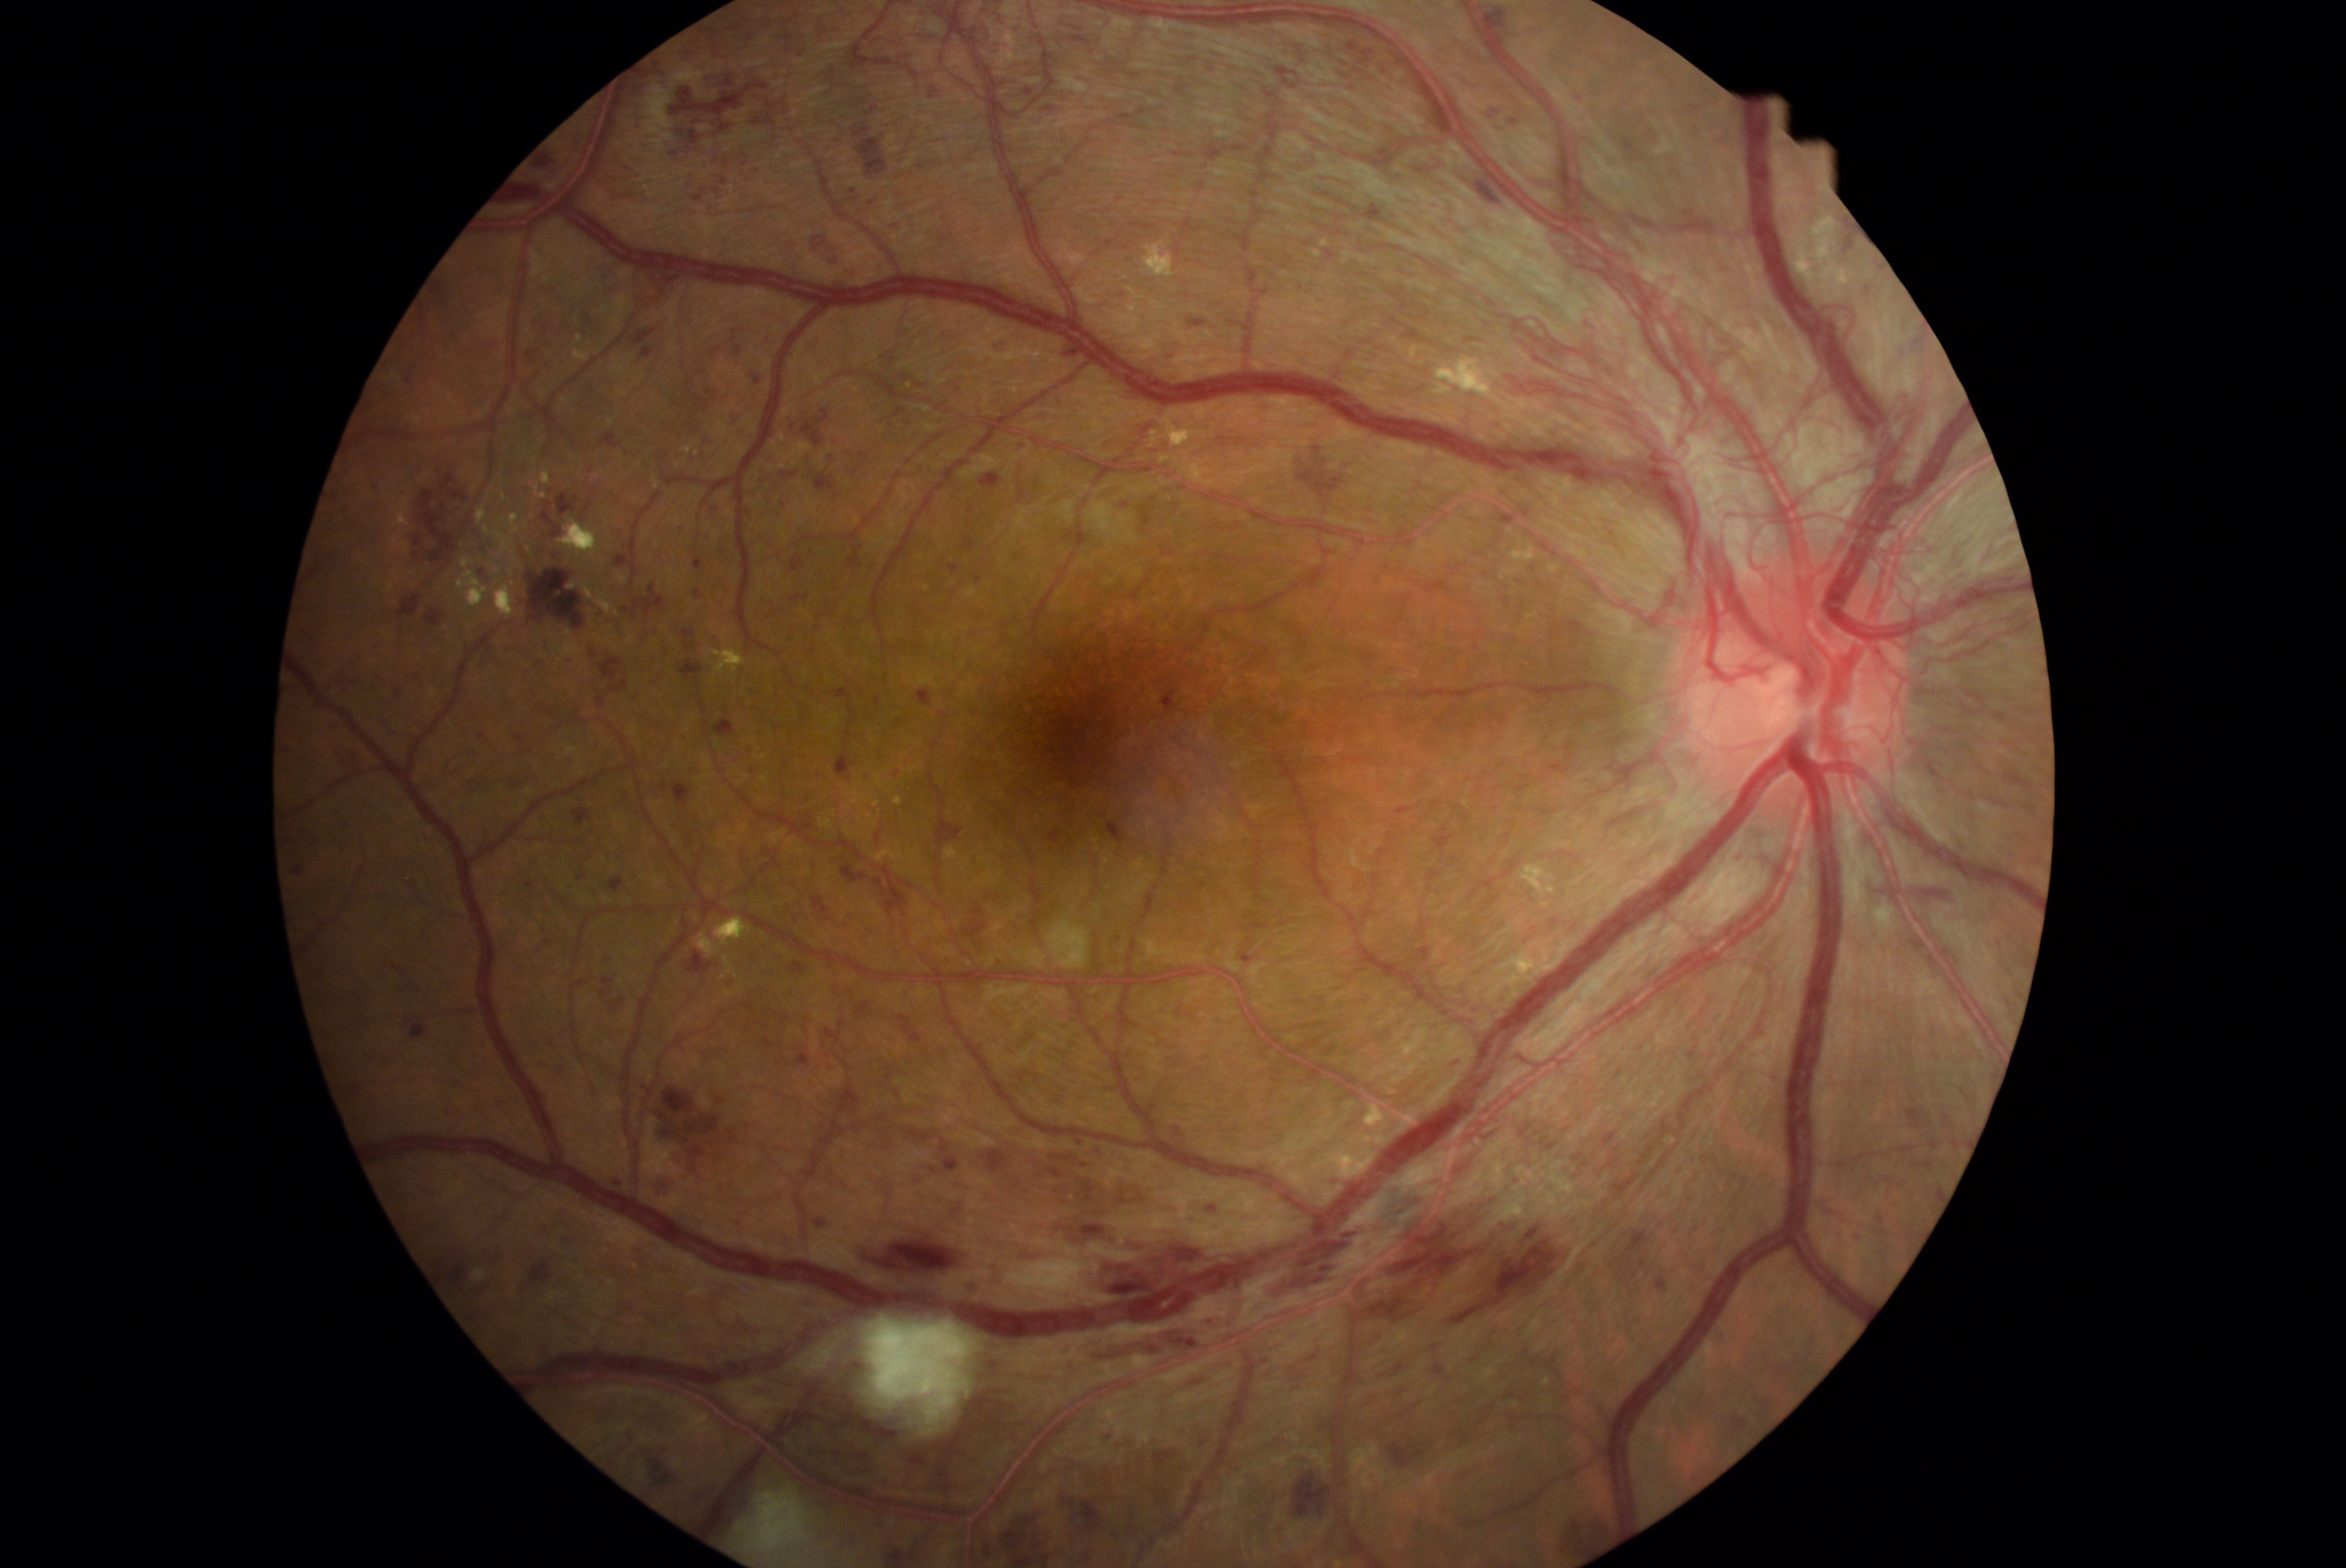

{"partial": true, "dr_grade": 4, "lesions": {"he": [[443, 747, 481, 777], [1611, 1232, 1649, 1279], [1489, 16, 1517, 29], [1030, 101, 1062, 122], [319, 655, 376, 711], [722, 583, 732, 597], [603, 802, 612, 813], [1843, 234, 1856, 253], [1872, 1210, 1886, 1224], [655, 1177, 675, 1197], [846, 553, 863, 570], [435, 283, 448, 296], [797, 1047, 812, 1065], [1062, 1219, 1232, 1319], [695, 559, 703, 570], [543, 637, 548, 652], [840, 184, 868, 203]], "he_small_centers": [[978, 579], [676, 154], [666, 787]]}}